Pediatric wide-field fundus photograph. 1240 by 1240 pixels:
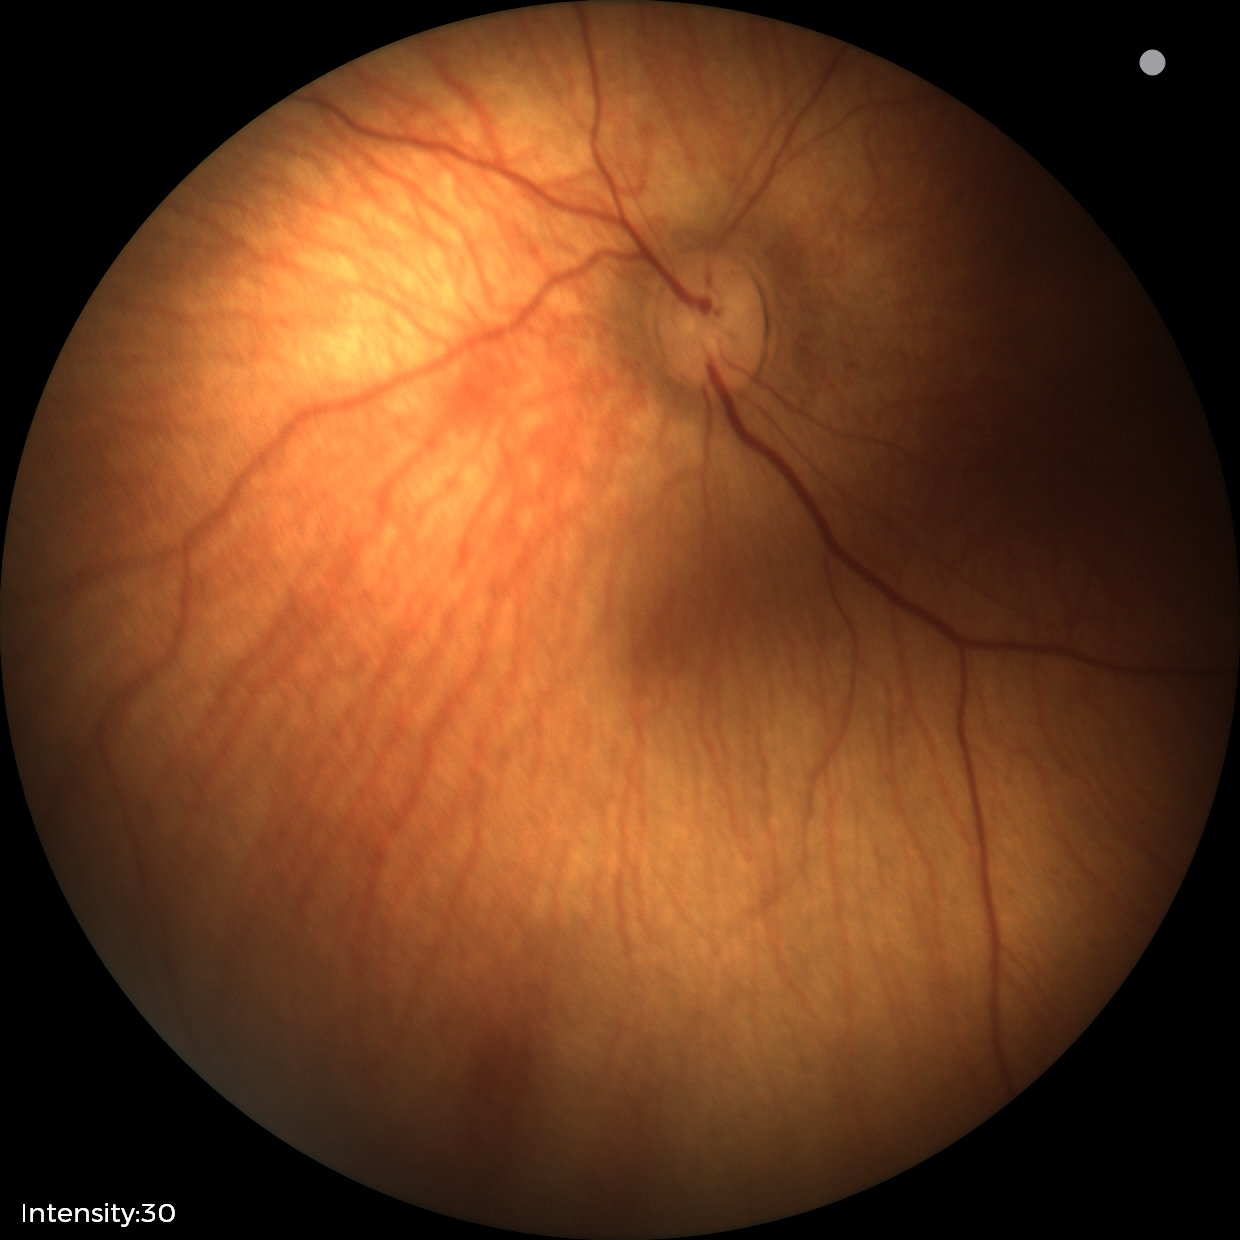 Physiological retinal appearance for postconceptual age.